FOV: 45 degrees; image size 2048x1536:
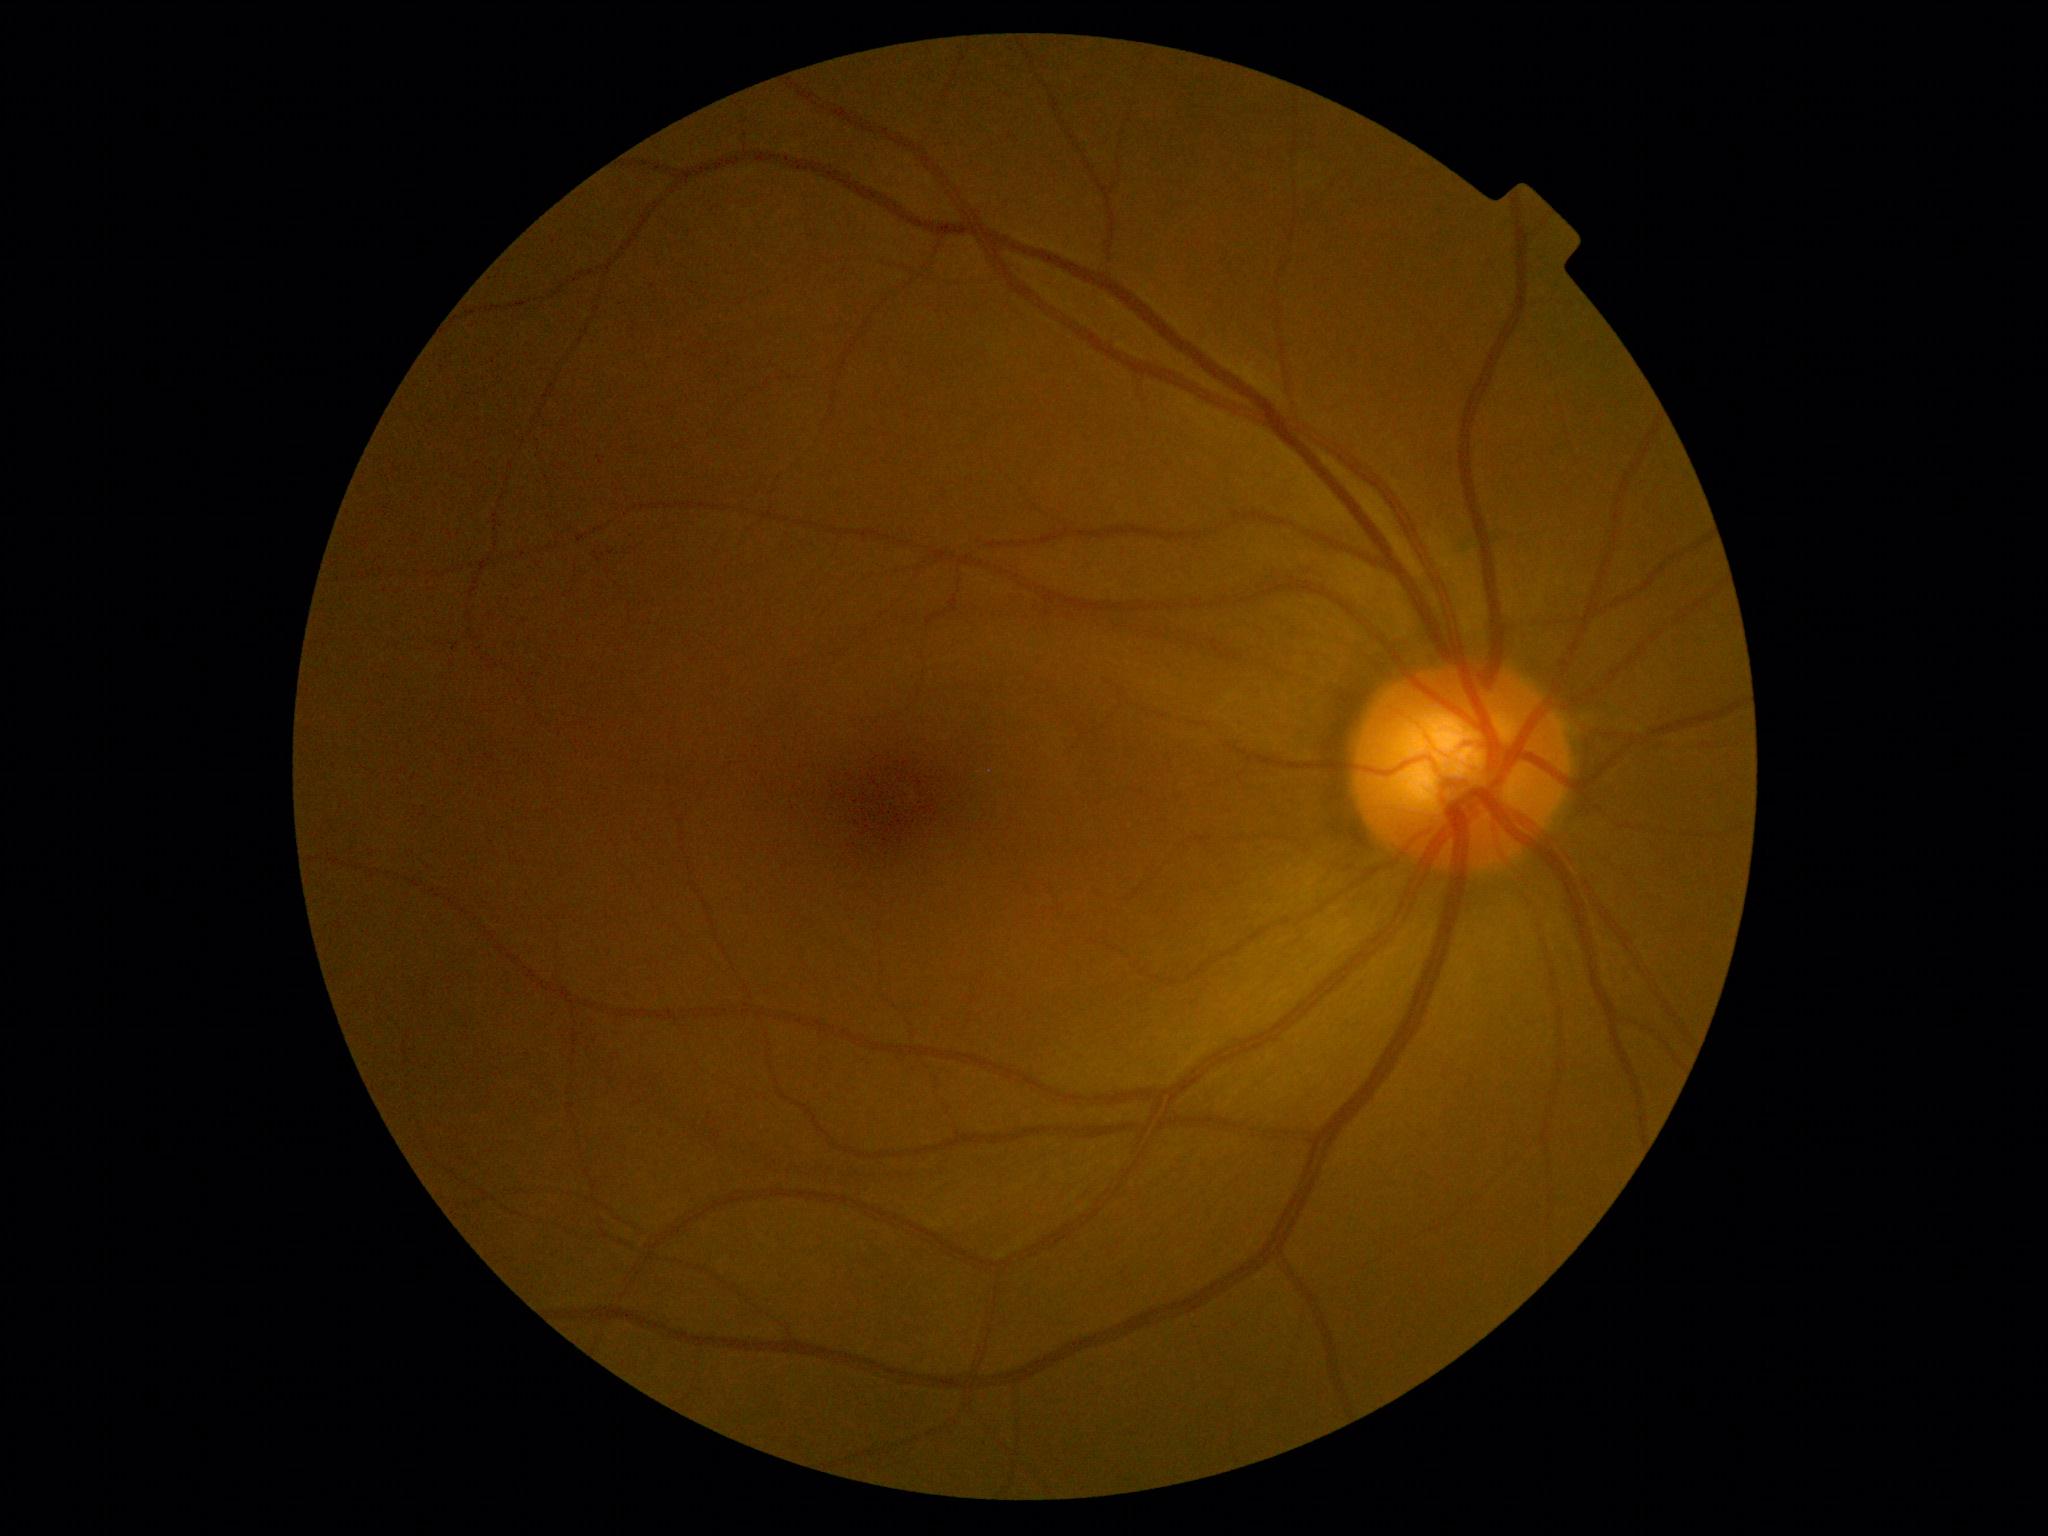
DR stage is 0.